1240x1240; wide-field fundus image from infant ROP screening — 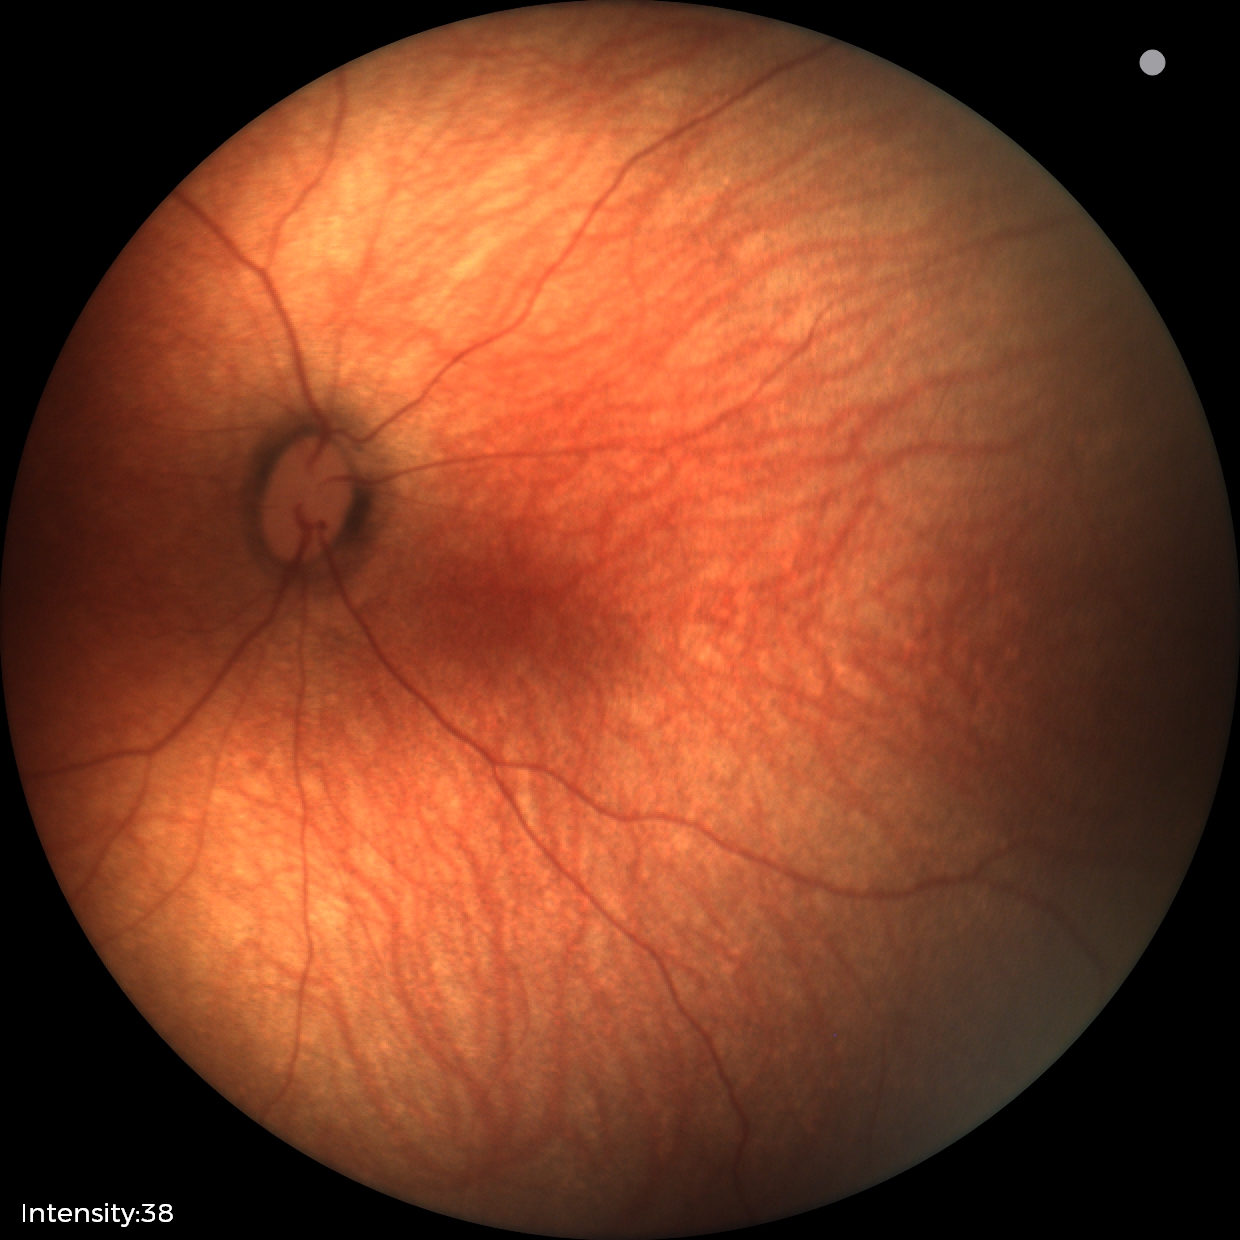
Screening examination diagnosed as physiological.